Fundus photo; graded on the modified Davis scale — 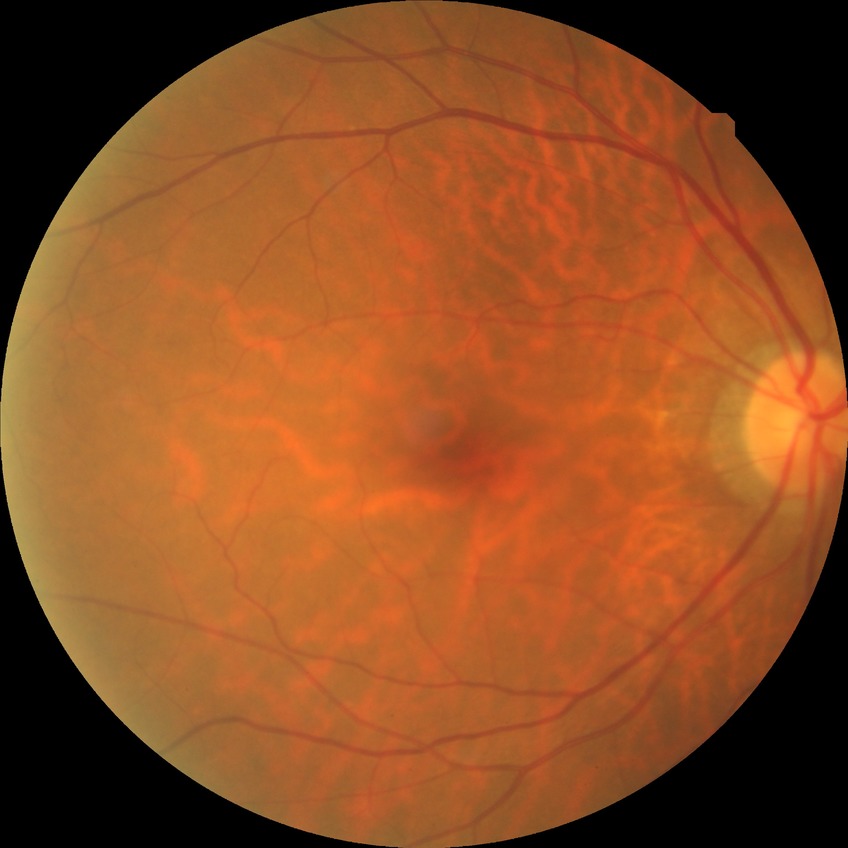 diabetic retinopathy (DR)=NDR (no diabetic retinopathy).